Nonmydriatic · 45° field of view: 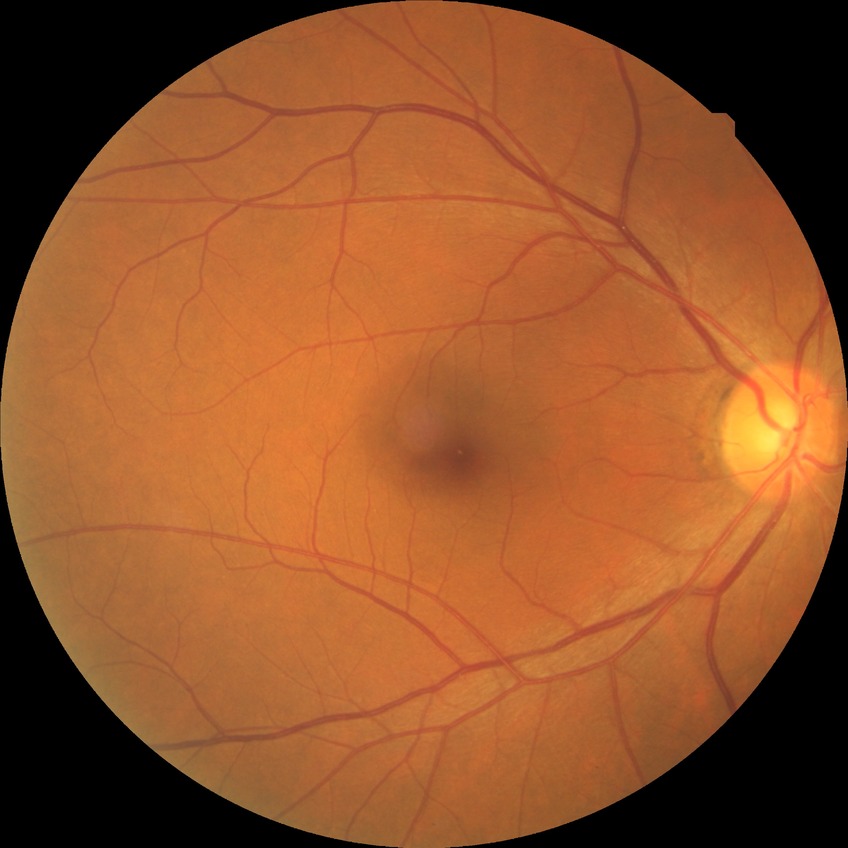
diabetic retinopathy (DR)=no diabetic retinopathy (NDR).